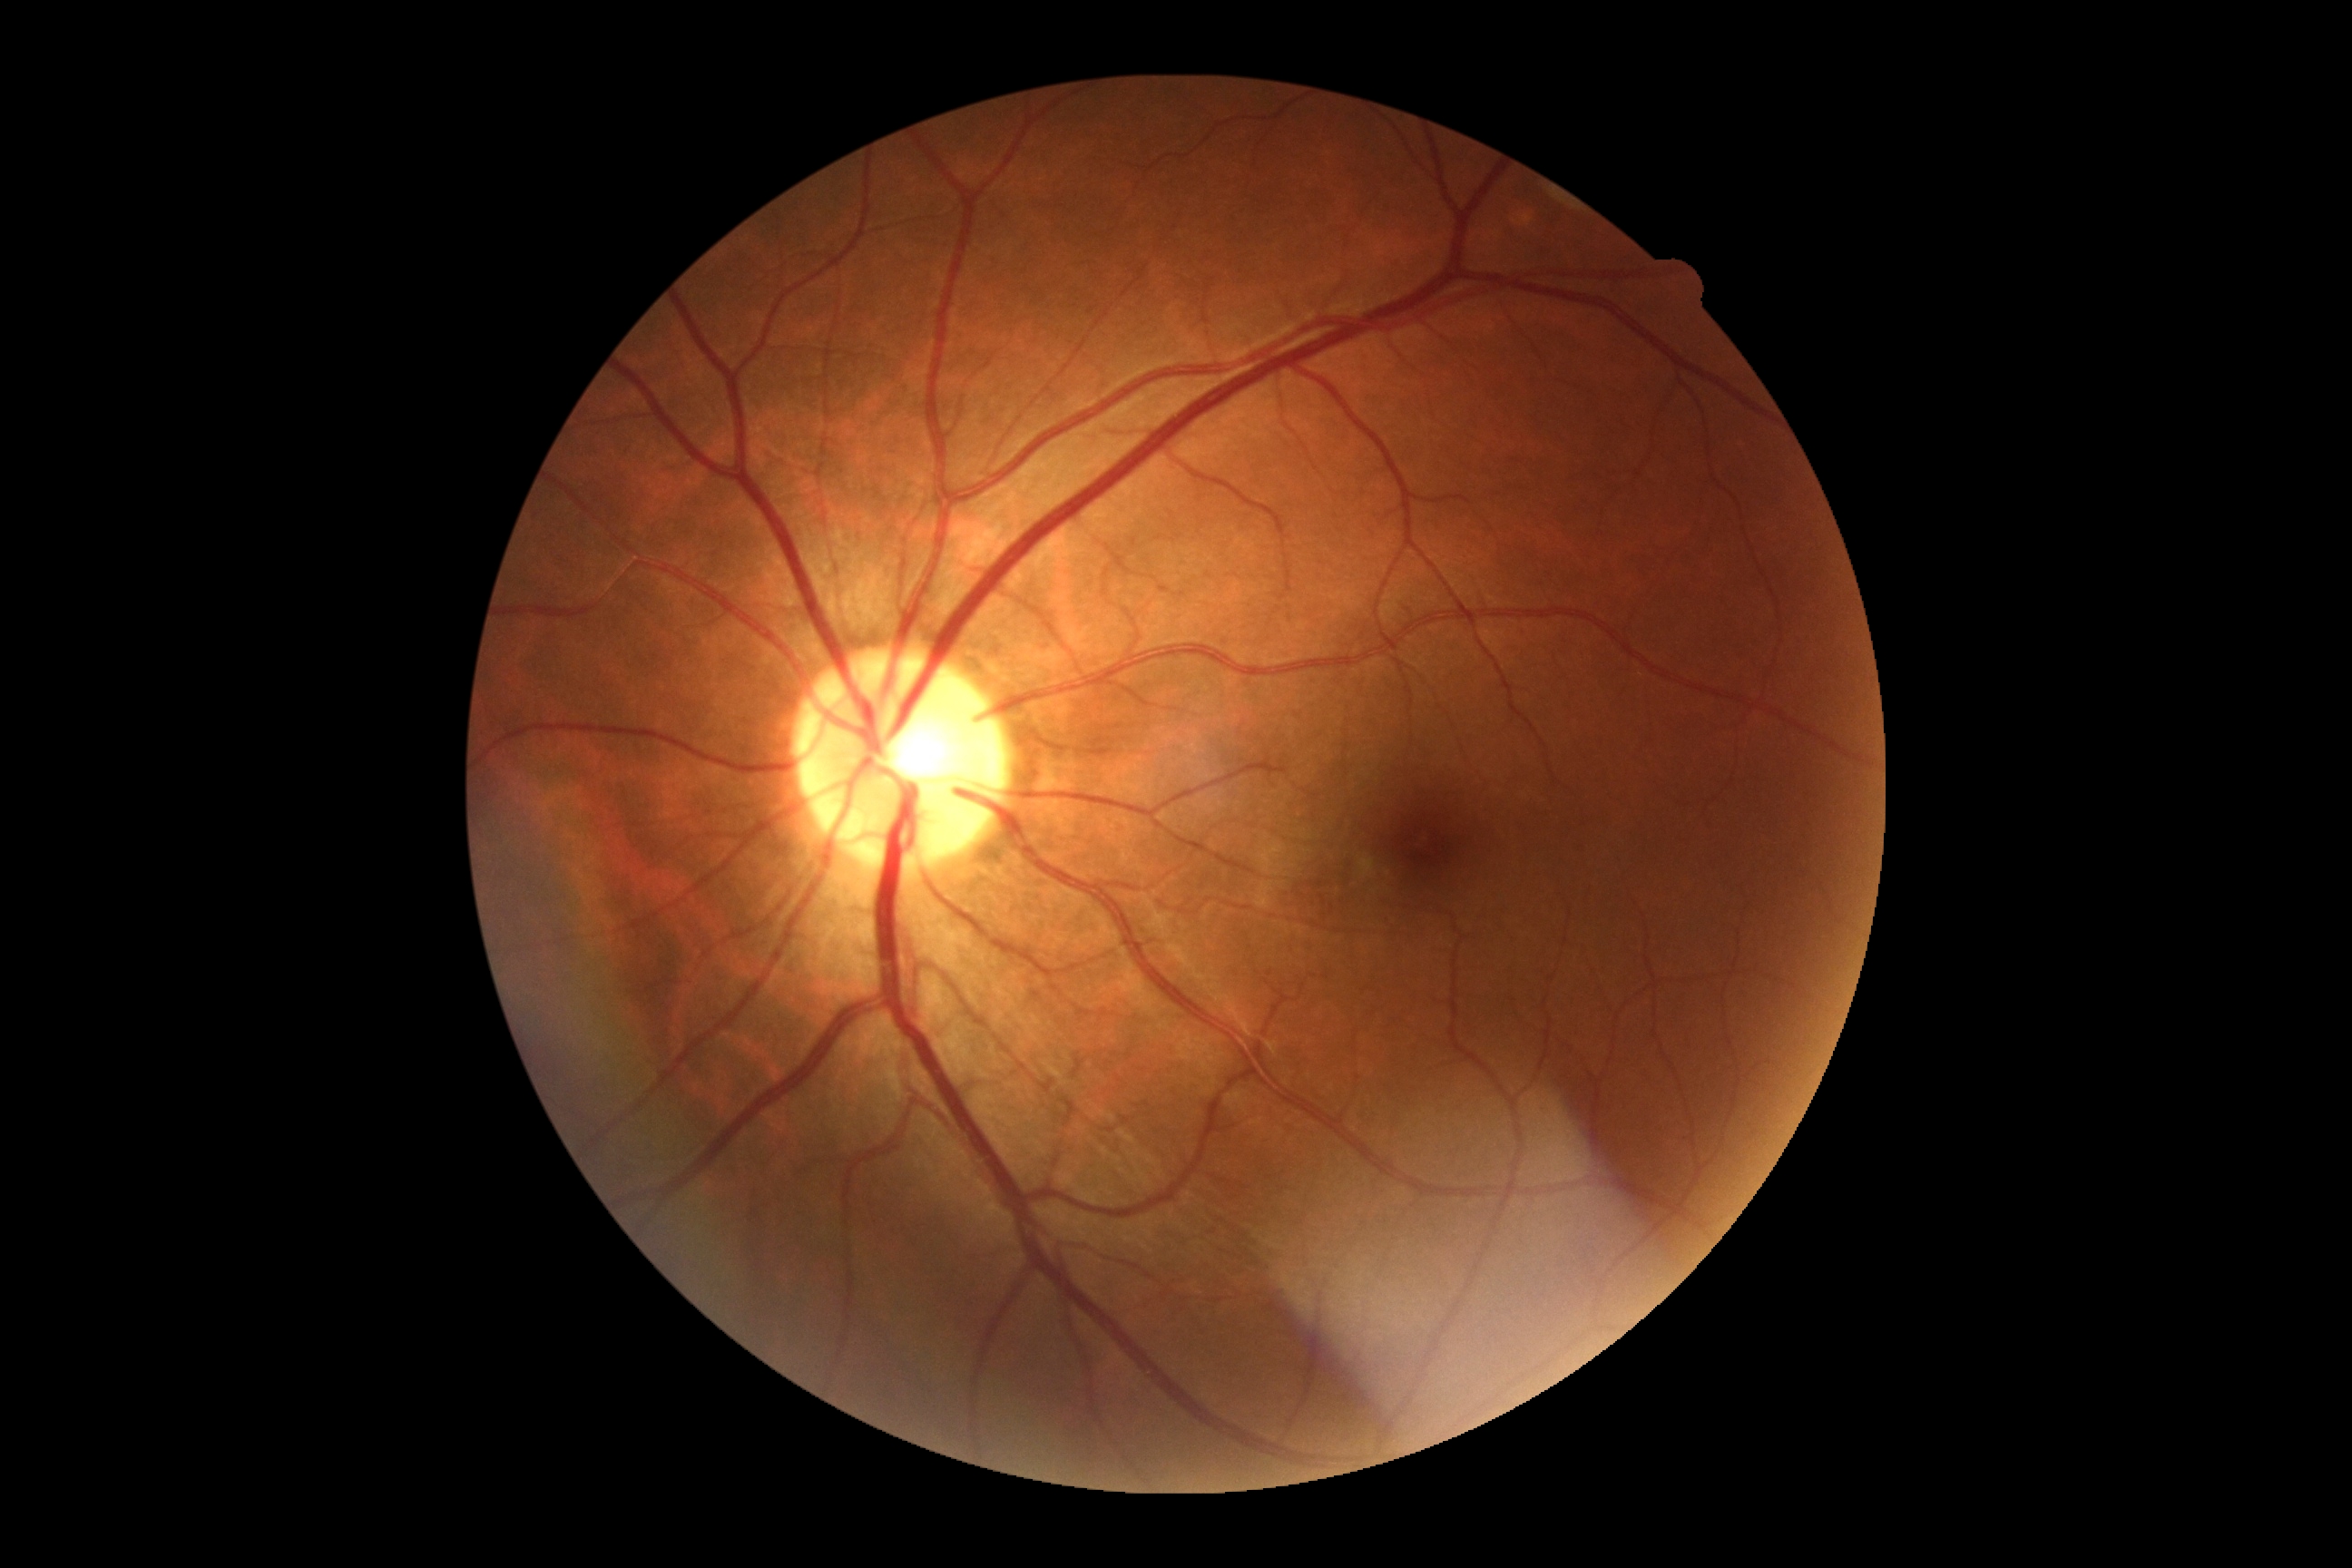 DR severity: 0.